Pupil-dilated · FOV: 50 degrees · posterior pole field covering the optic disc and macula · 2228 by 1652 pixels.
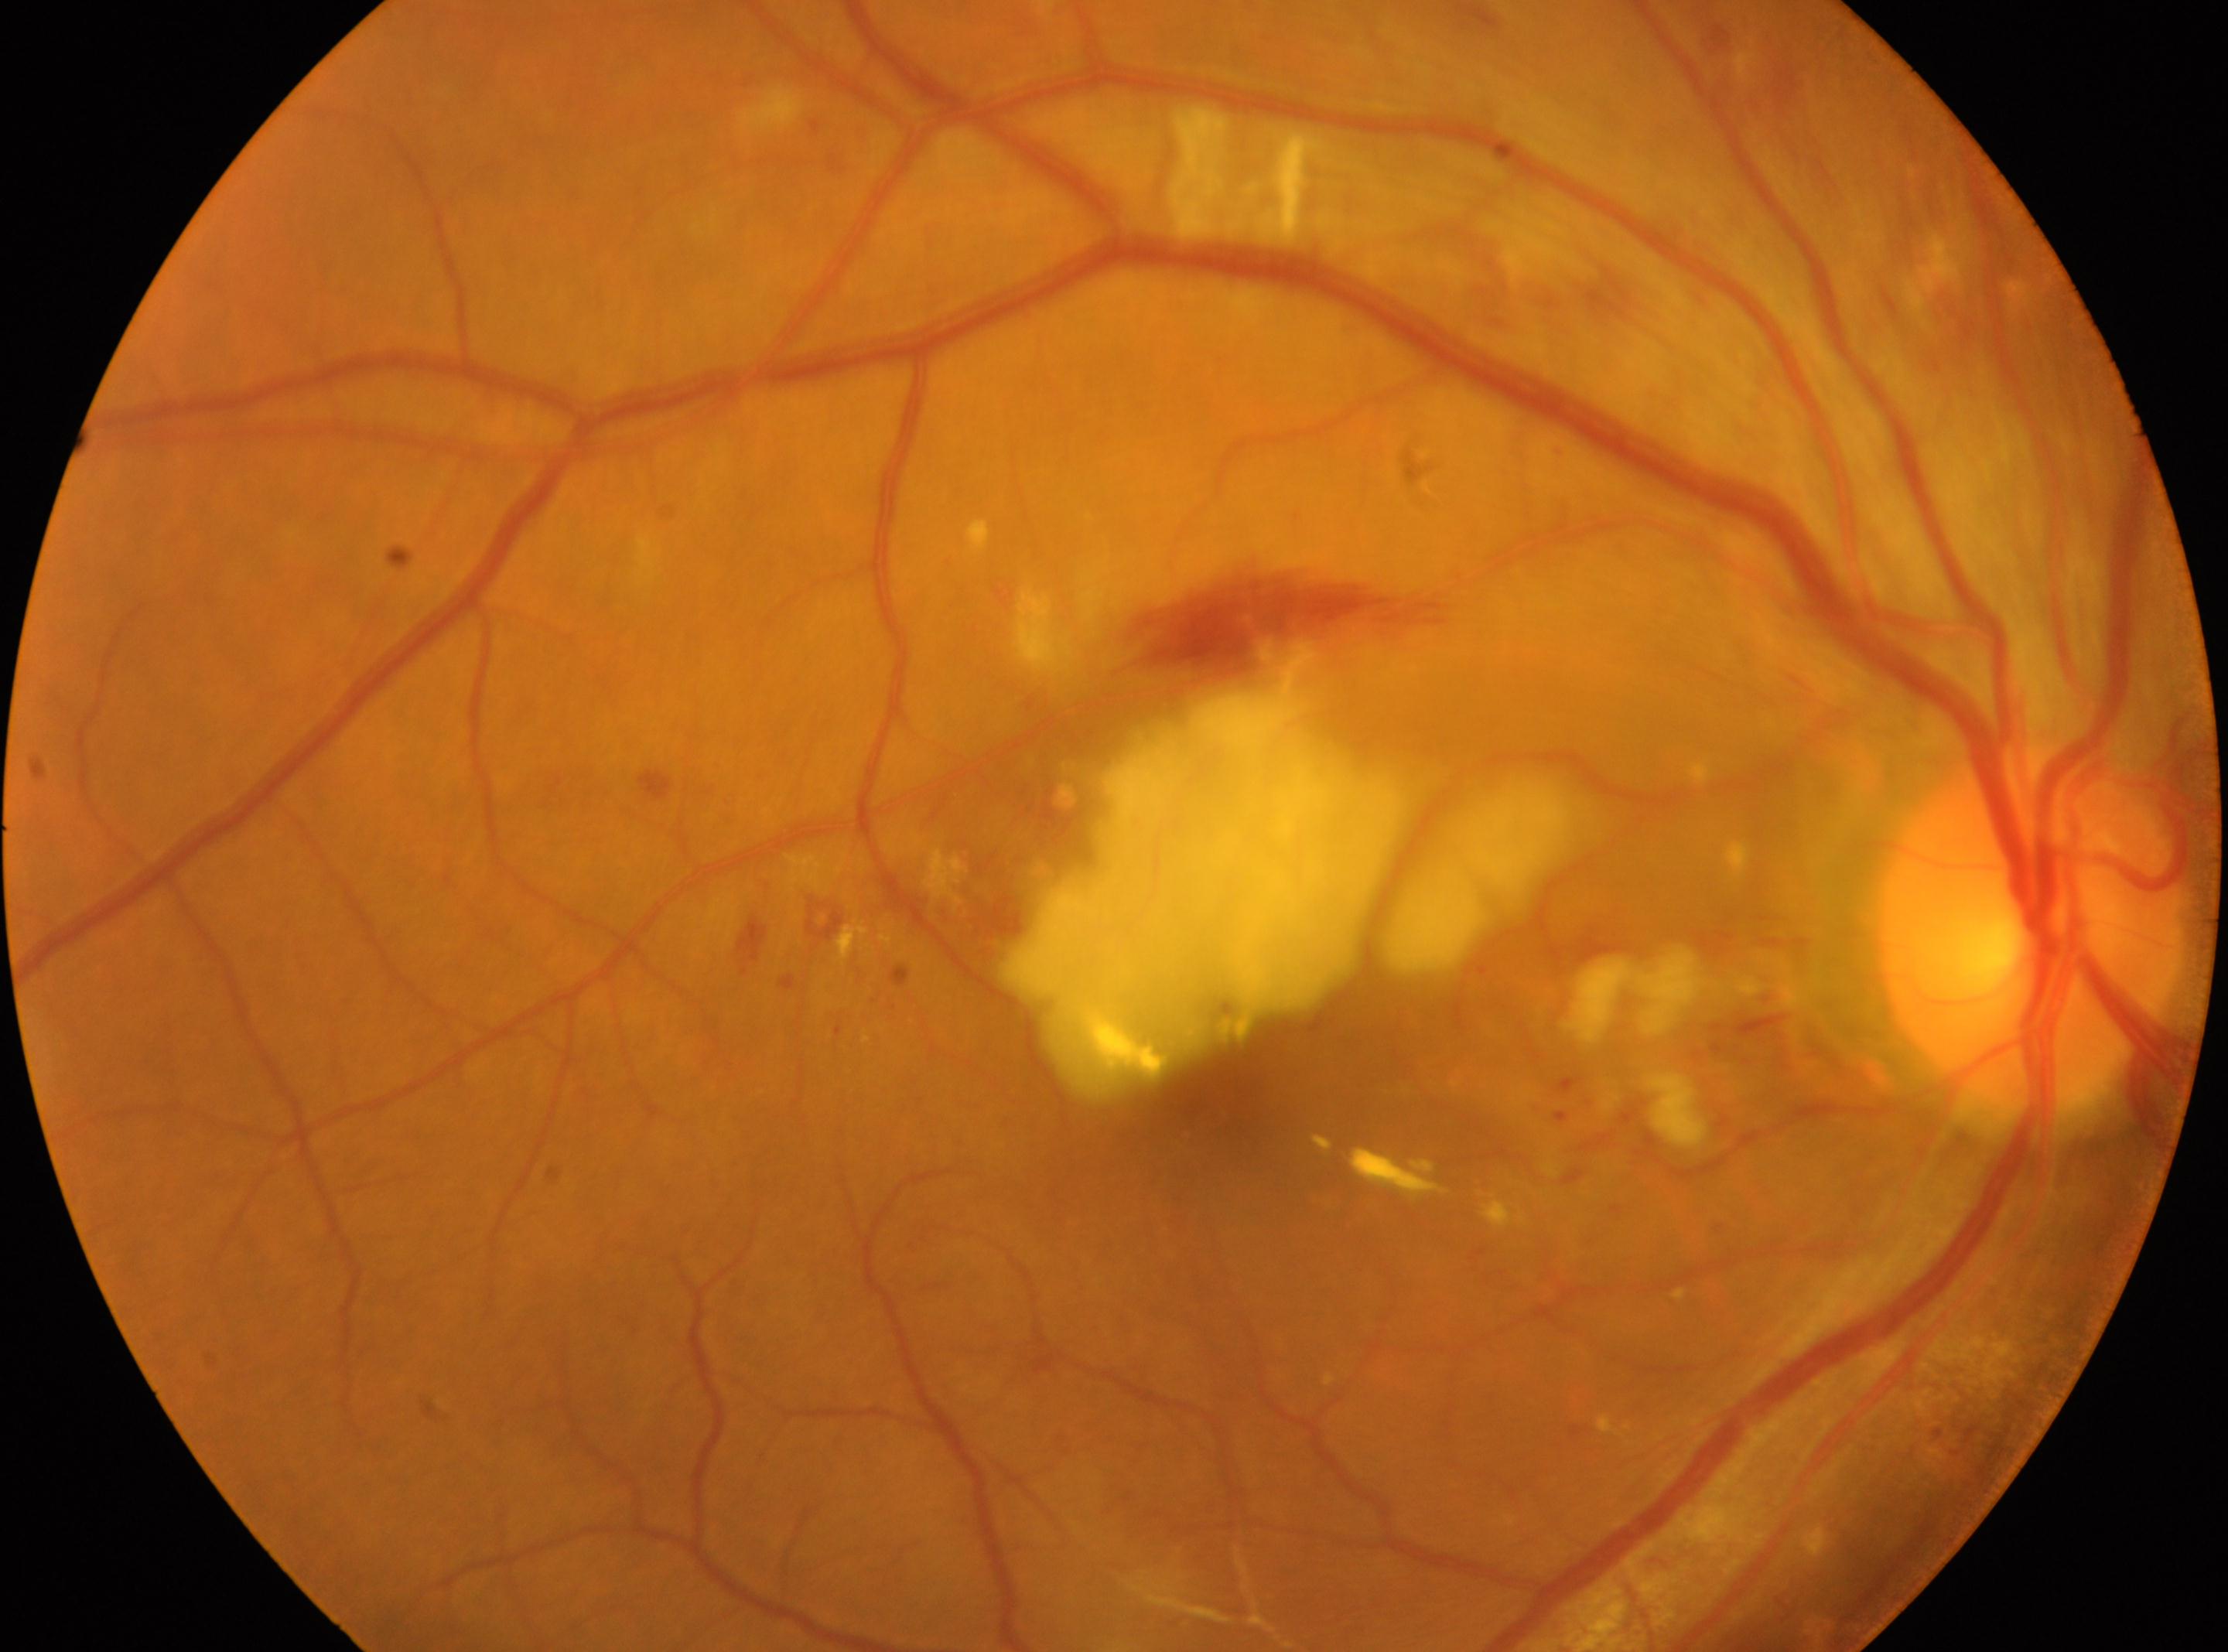

DR stage: grade 2.
Fovea located at 1228px, 1092px.
The optic disk is at 2028px, 929px.
This is the right eye.